Central corneal thickness: 527 µm; axial length (AL): 22.26 mm; woman; disc-centered field; visual field mean defect: -8.02 dB — 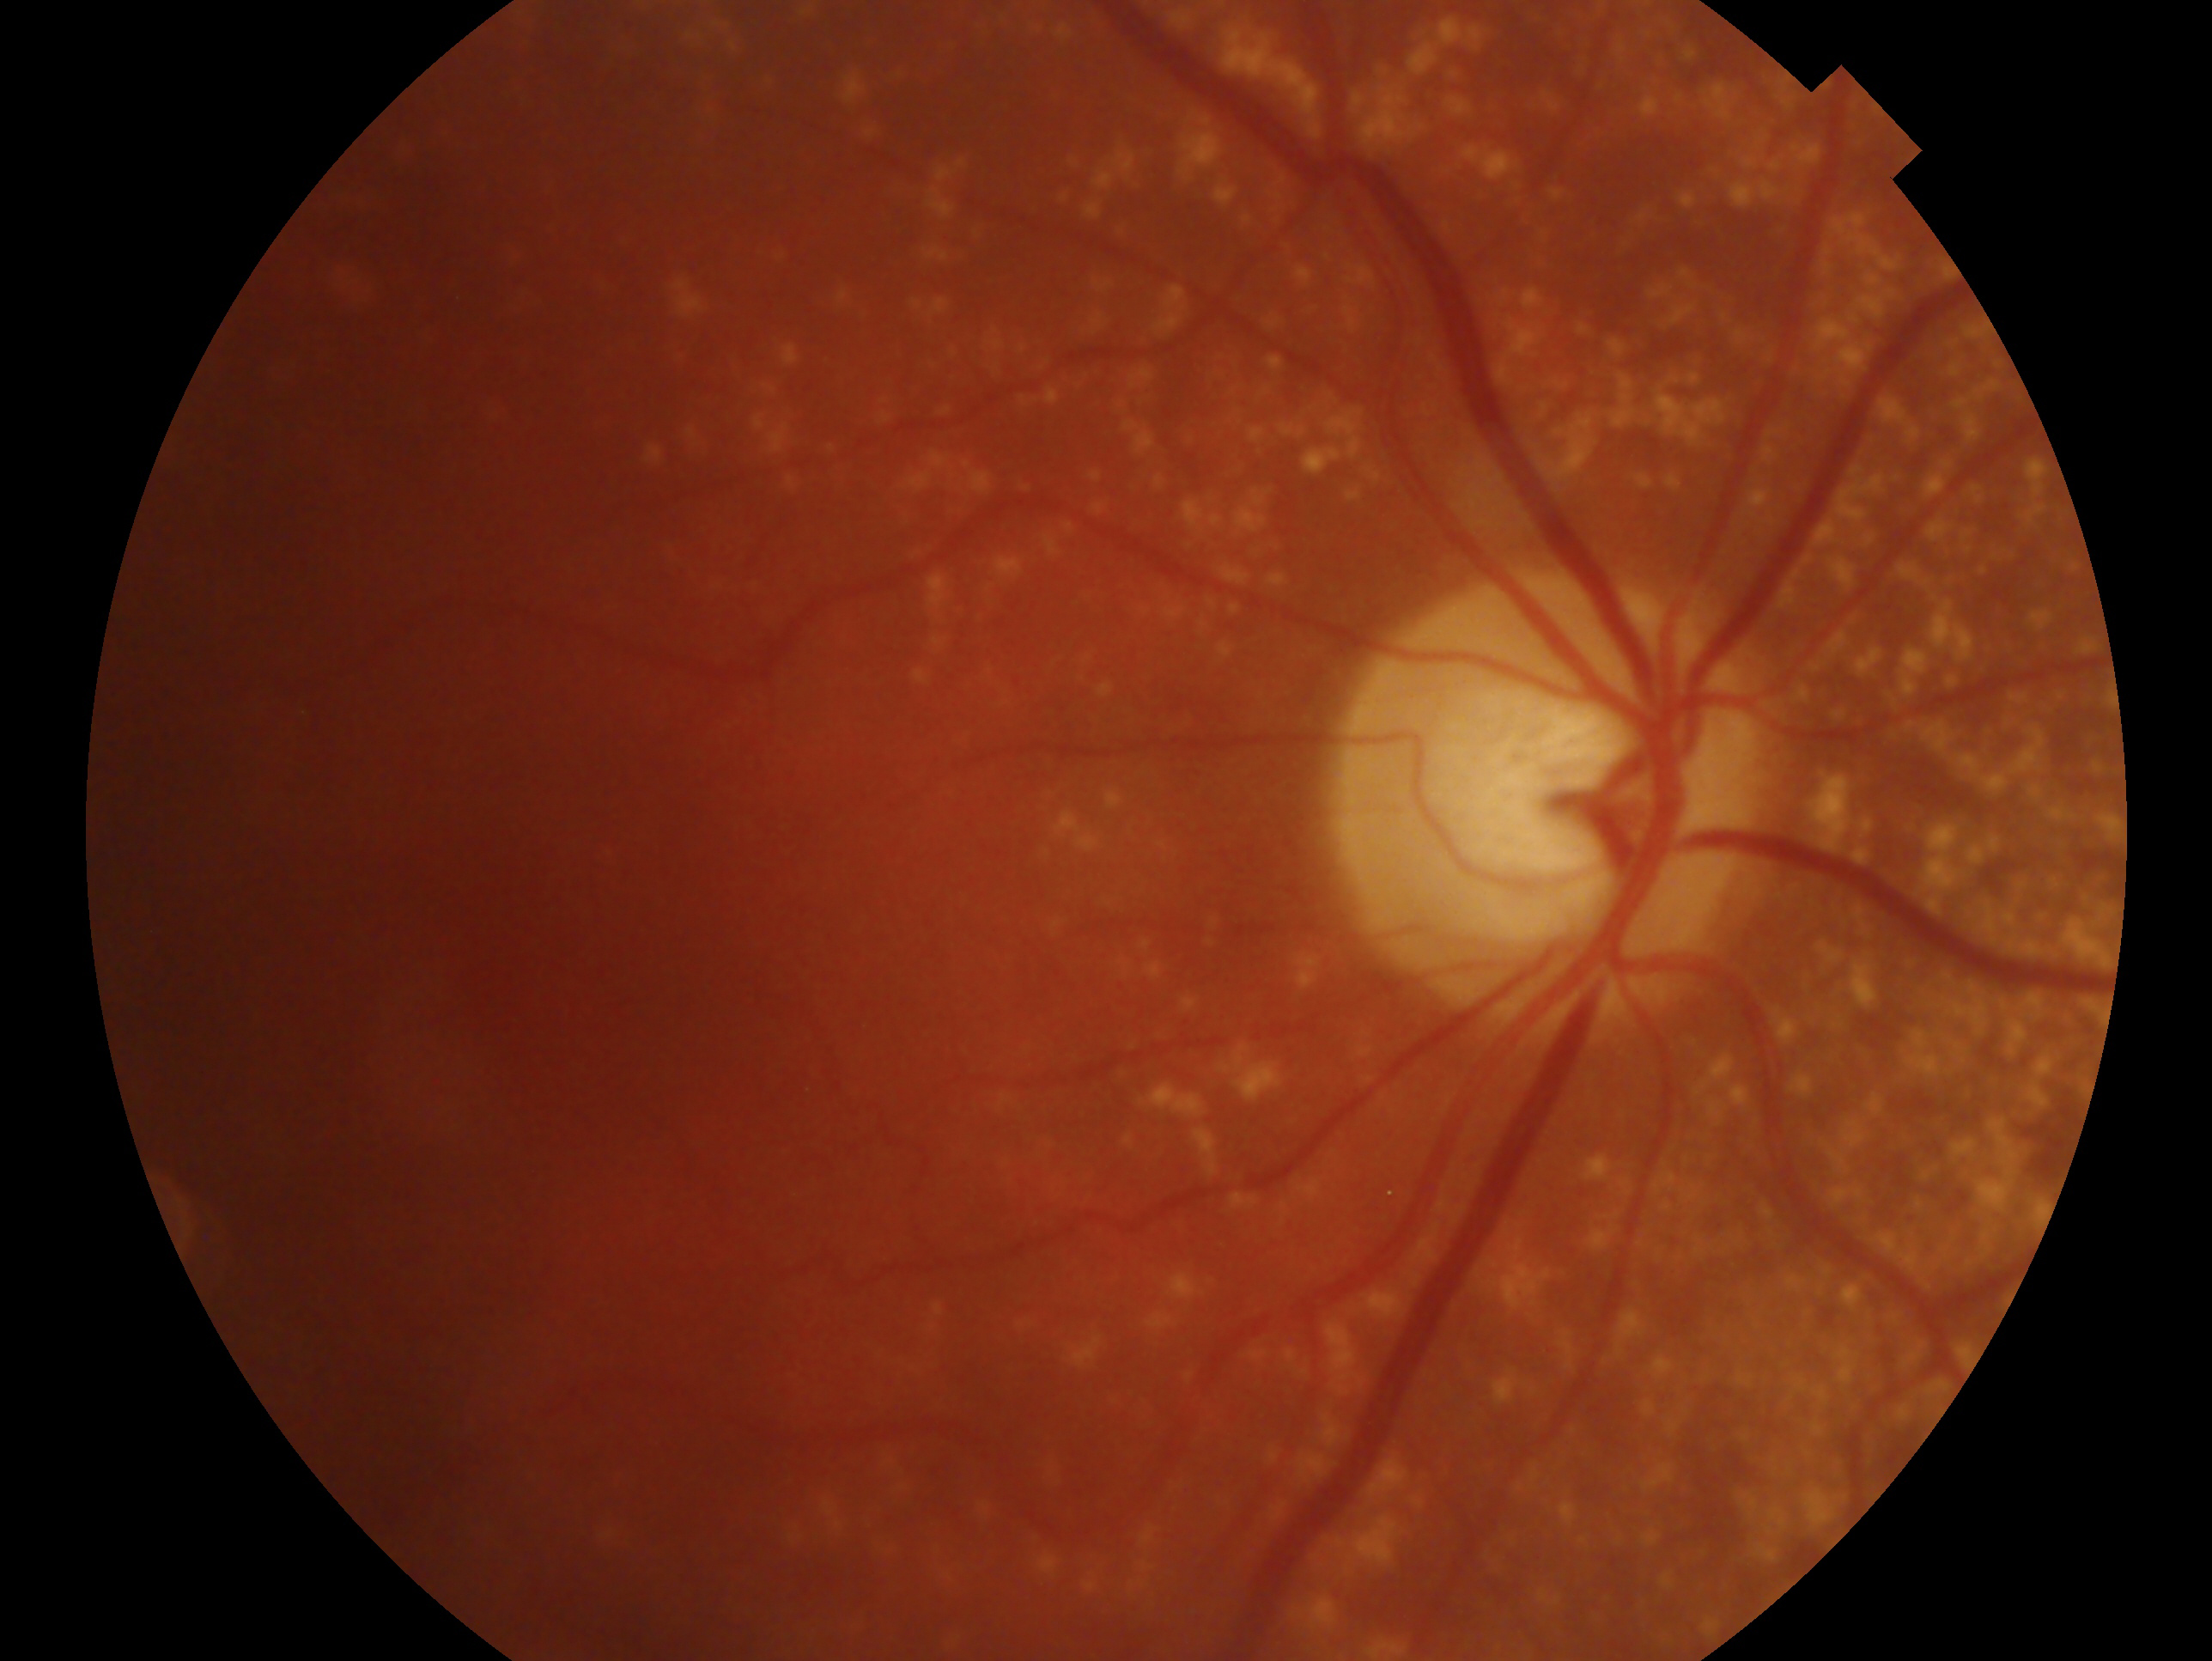
Glaucoma diagnosis — consistent with glaucoma. Imaged eye: oculus dexter.